Wide-field fundus image from infant ROP screening · image size 1240x1240 · captured with the Phoenix ICON (100° field of view): 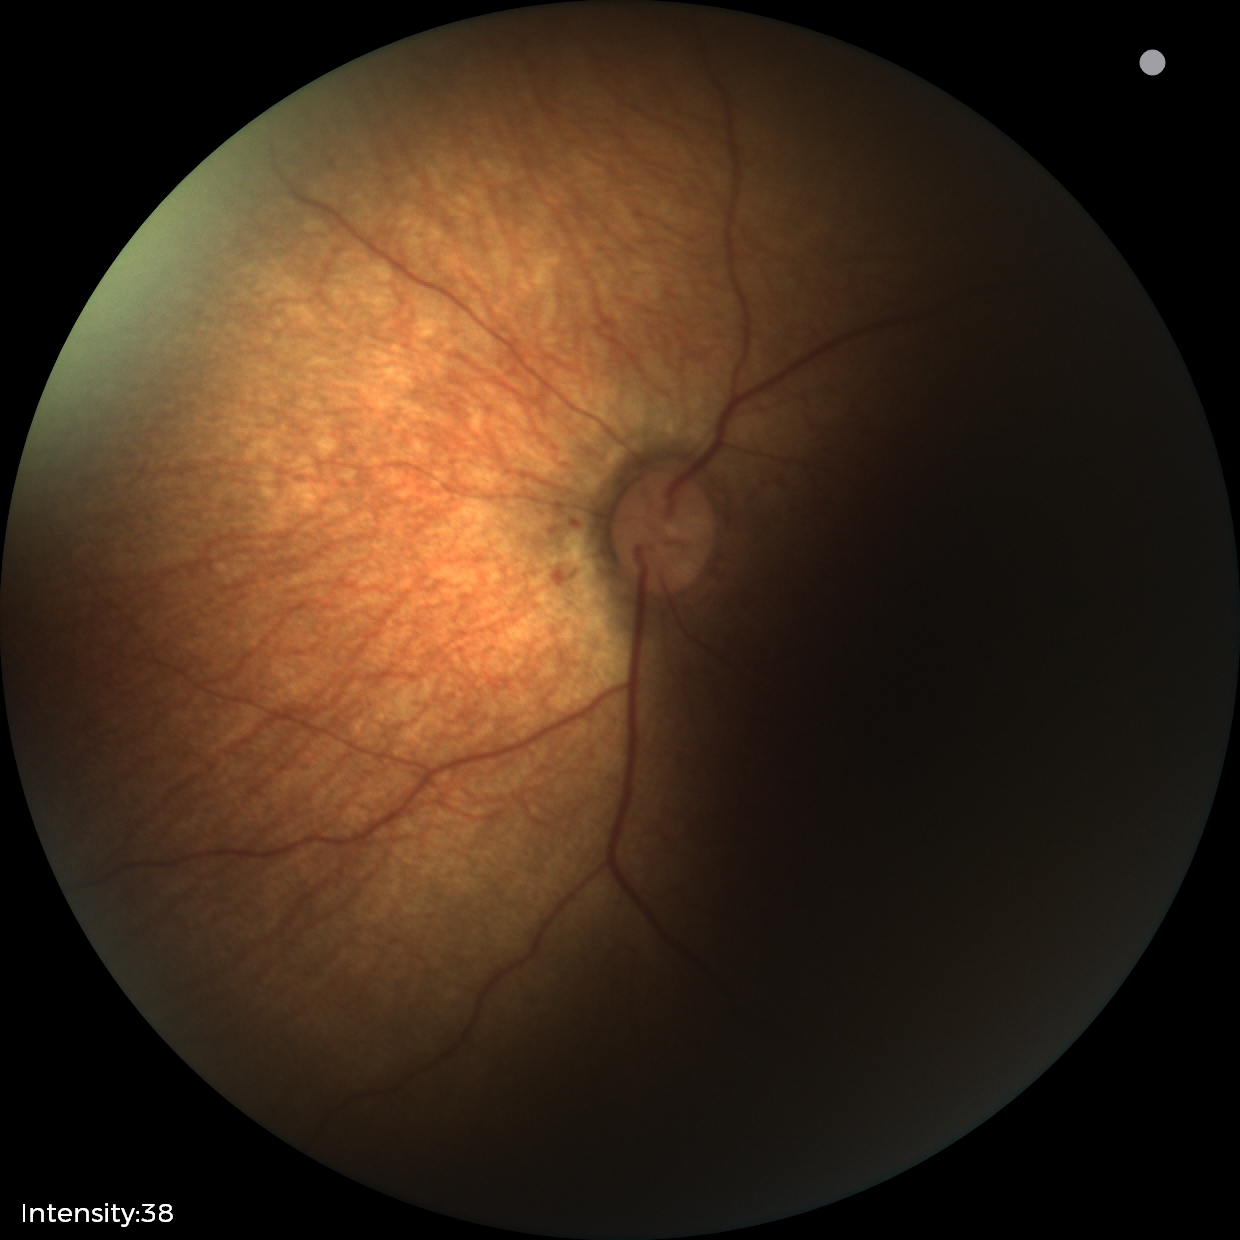 Screening examination with no abnormal retinal findings.